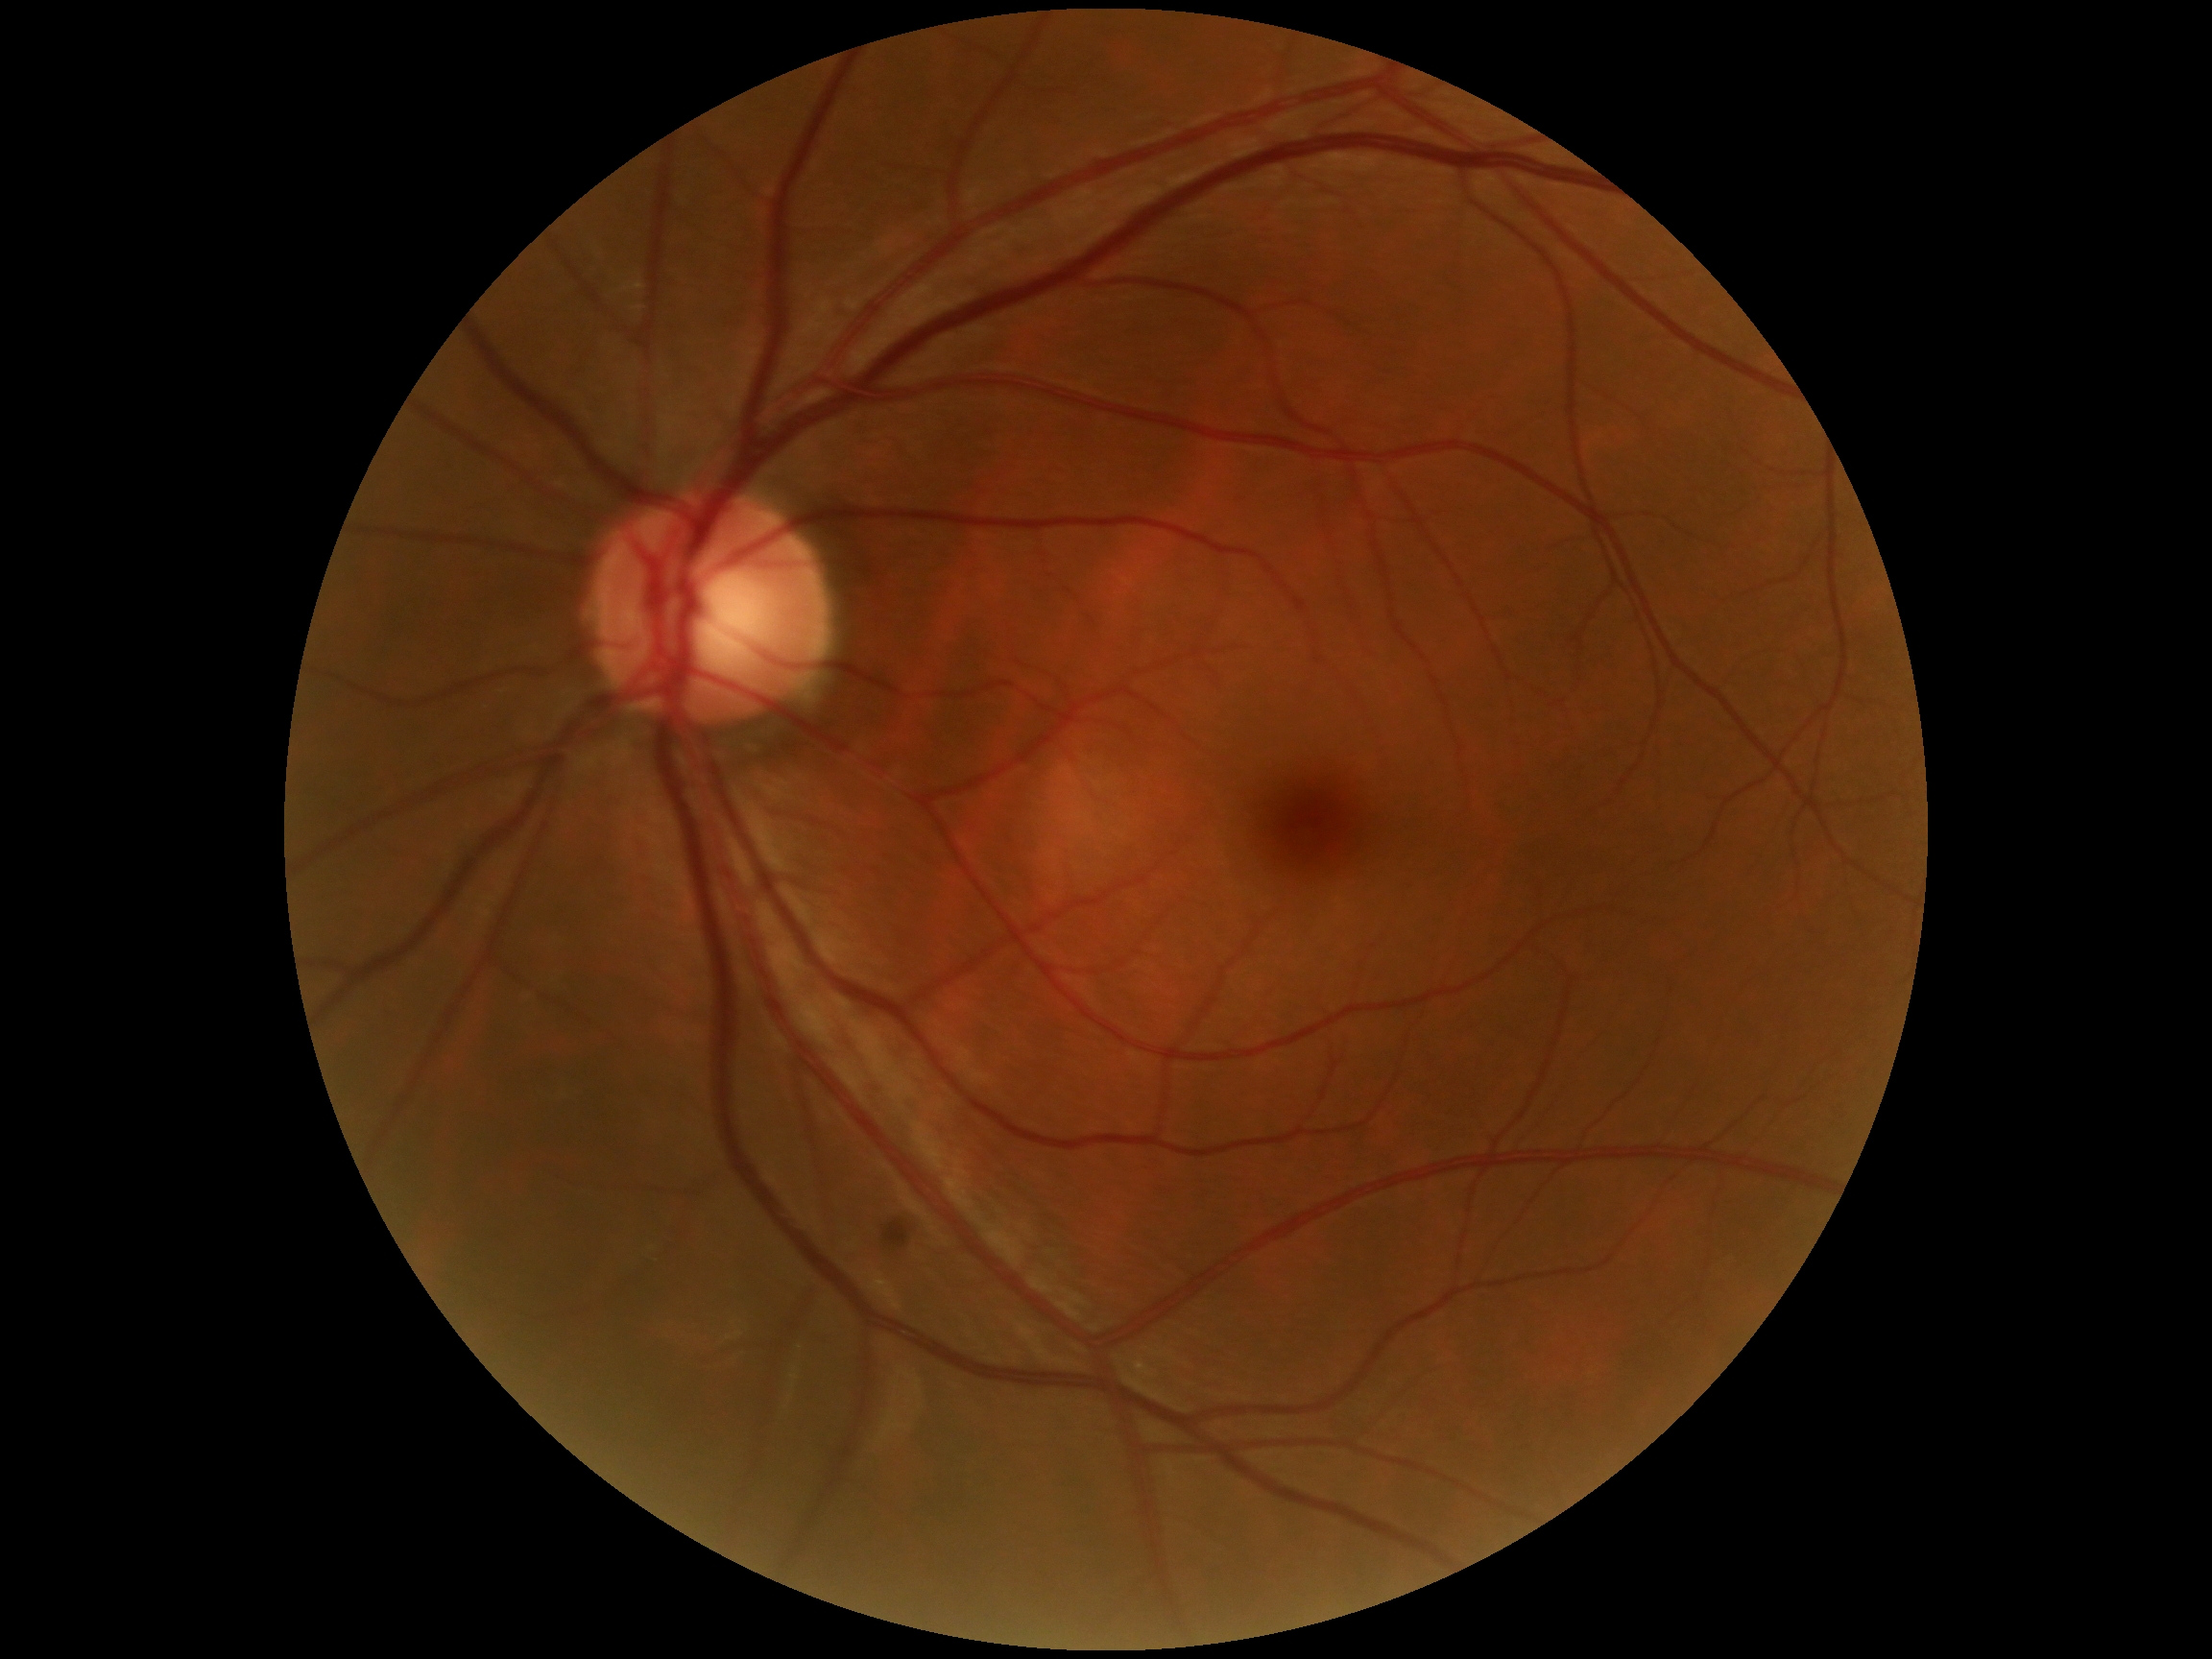
Annotations:
- DR grade — moderate non-proliferative diabetic retinopathy (2) — more than just microaneurysms but less than severe NPDR